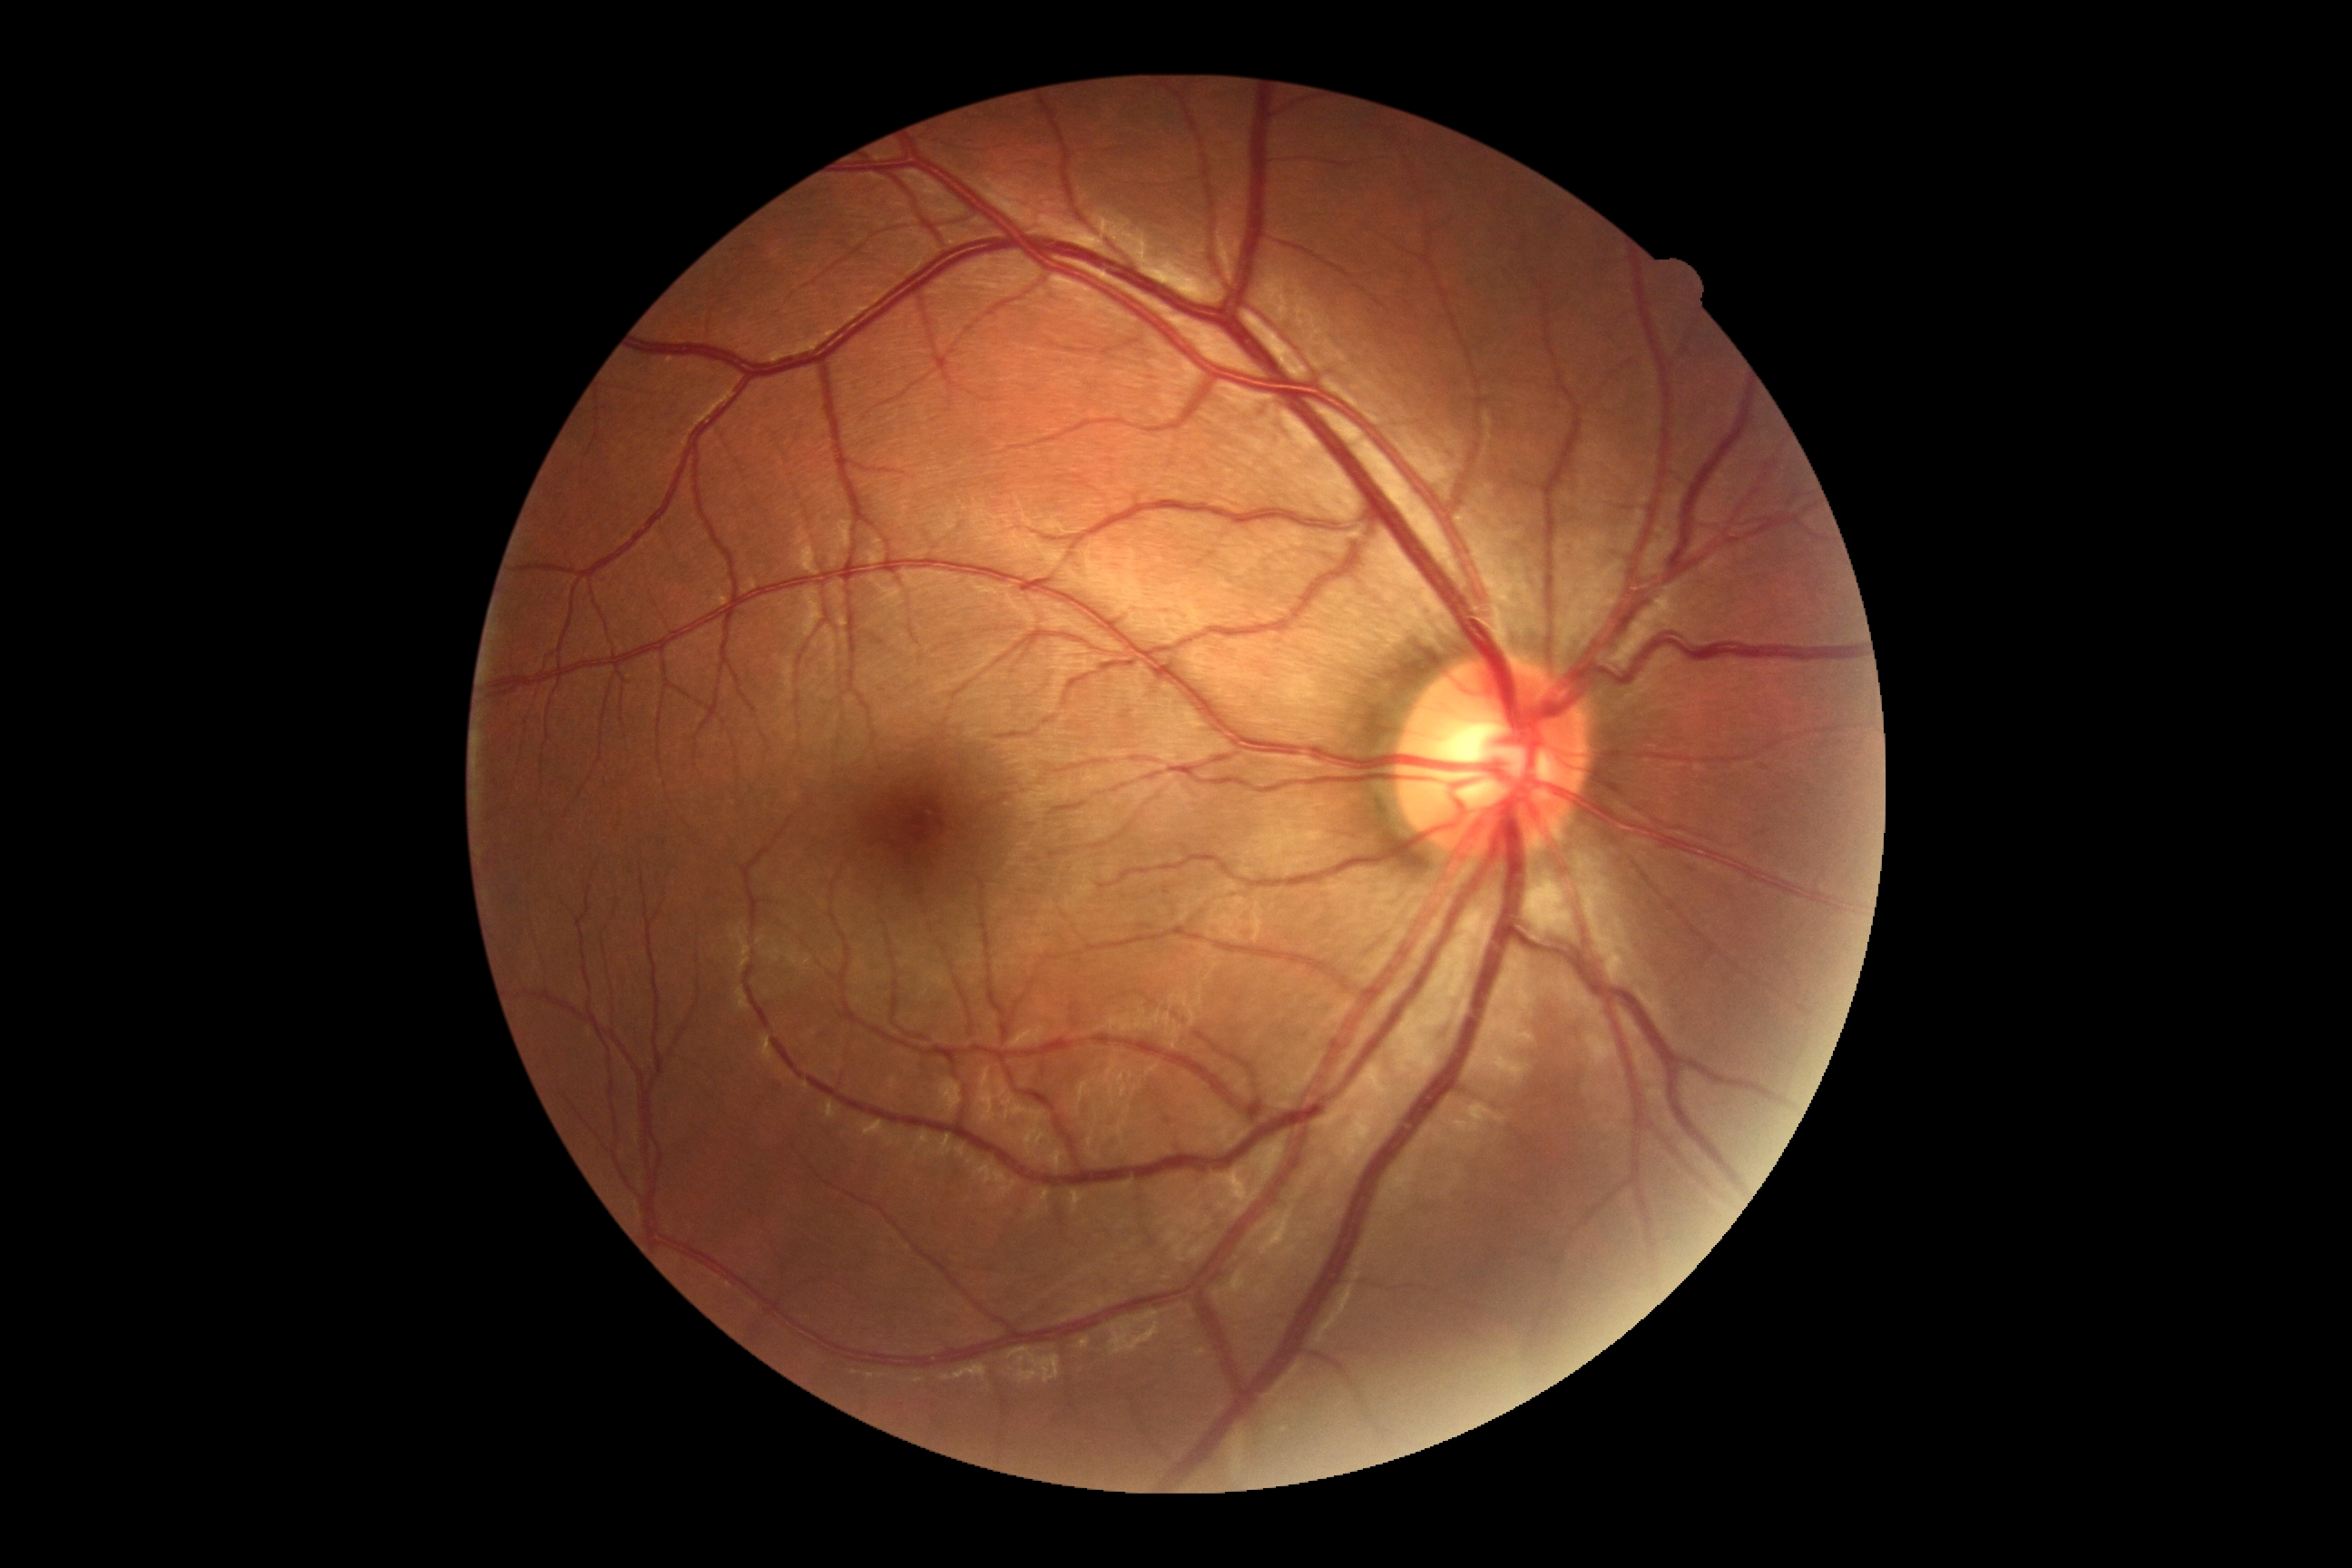
DR stage = no apparent retinopathy (grade 0).